1440 by 1080 pixels · pediatric retinal photograph (wide-field) · 130° field of view (Natus RetCam Envision): 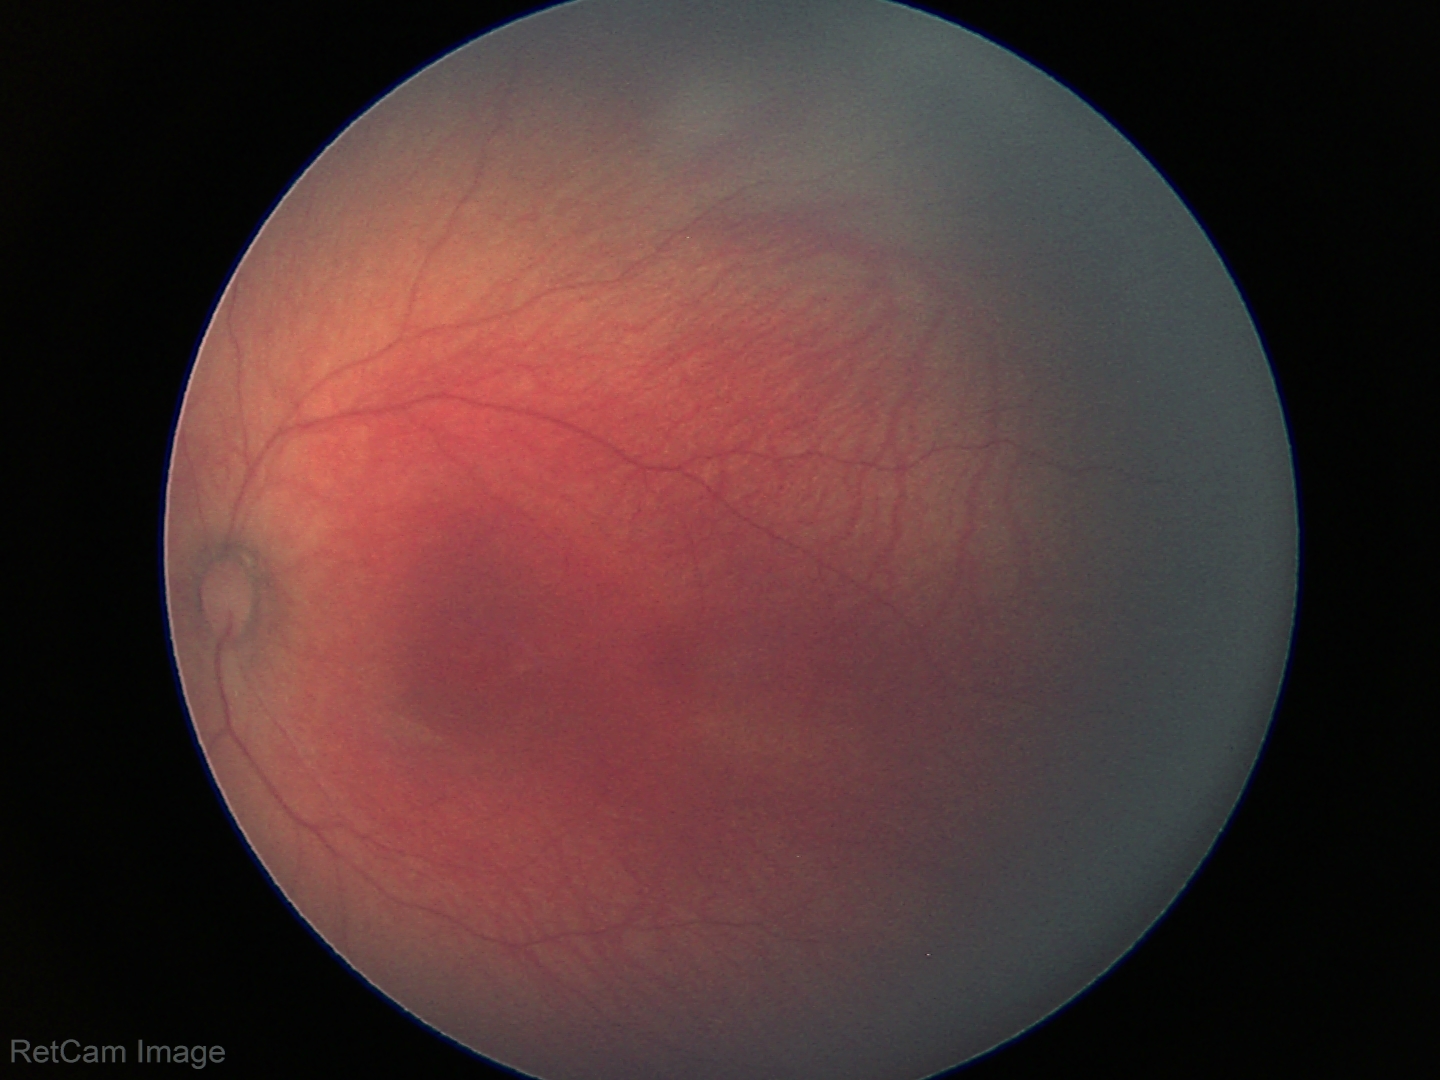
Screening diagnosis: no abnormal retinal findings.